1240x1240 · wide-field fundus photograph of an infant
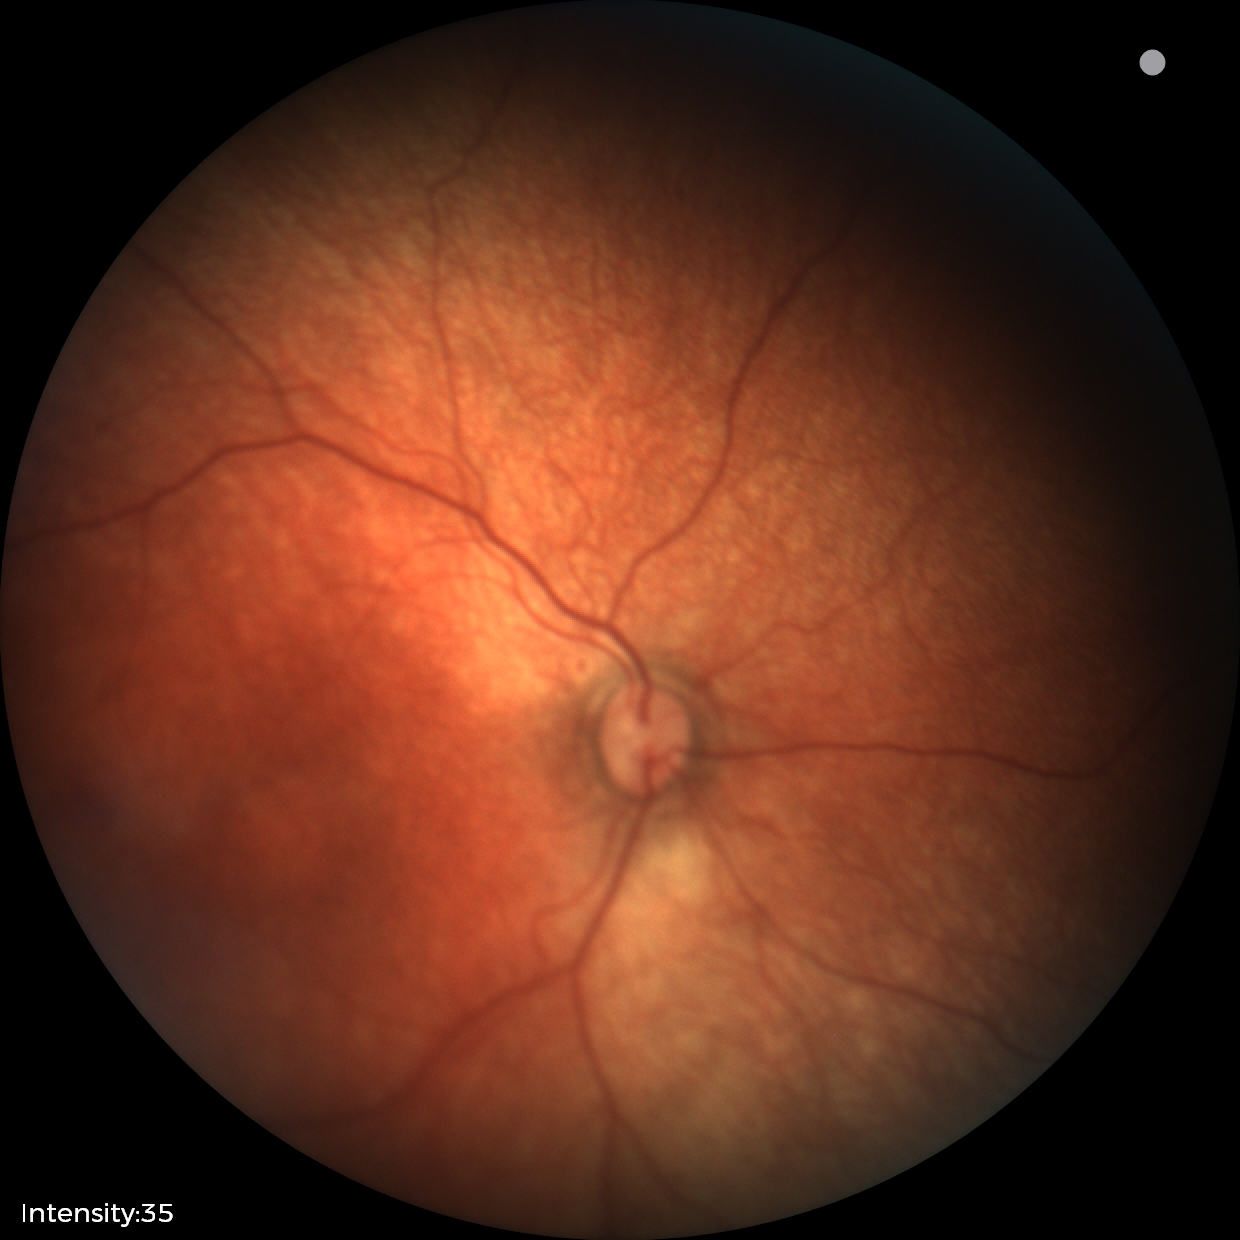
Screening examination with no abnormal retinal findings.